Image size 848x848. Nonmydriatic fundus photograph. 45° field of view. Davis DR grading. Fundus photo.
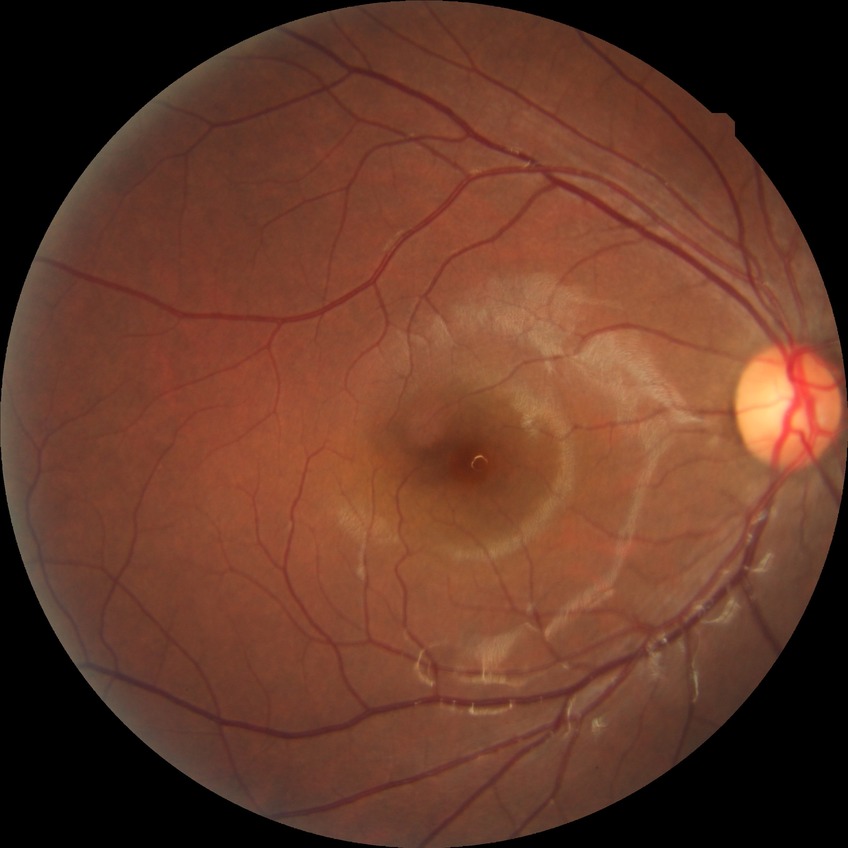
DR grade is NDR.